Wide-field contact fundus photograph of an infant. 1440 x 1080 pixels
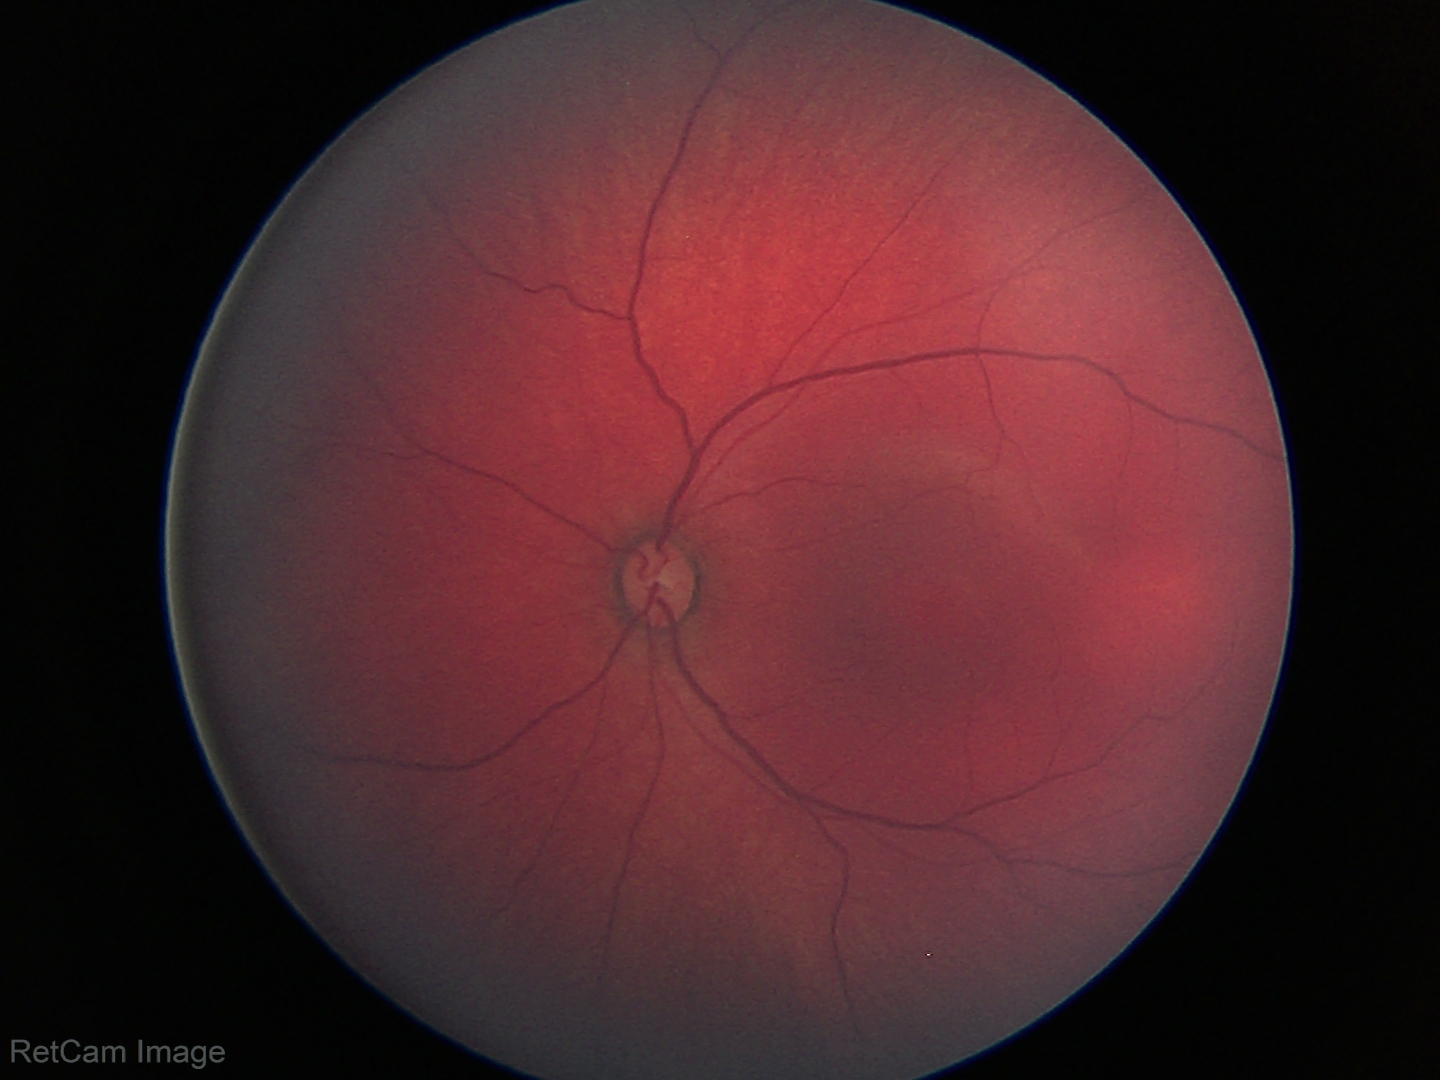
Examination with physiological retinal findings.